Modified Davis classification: 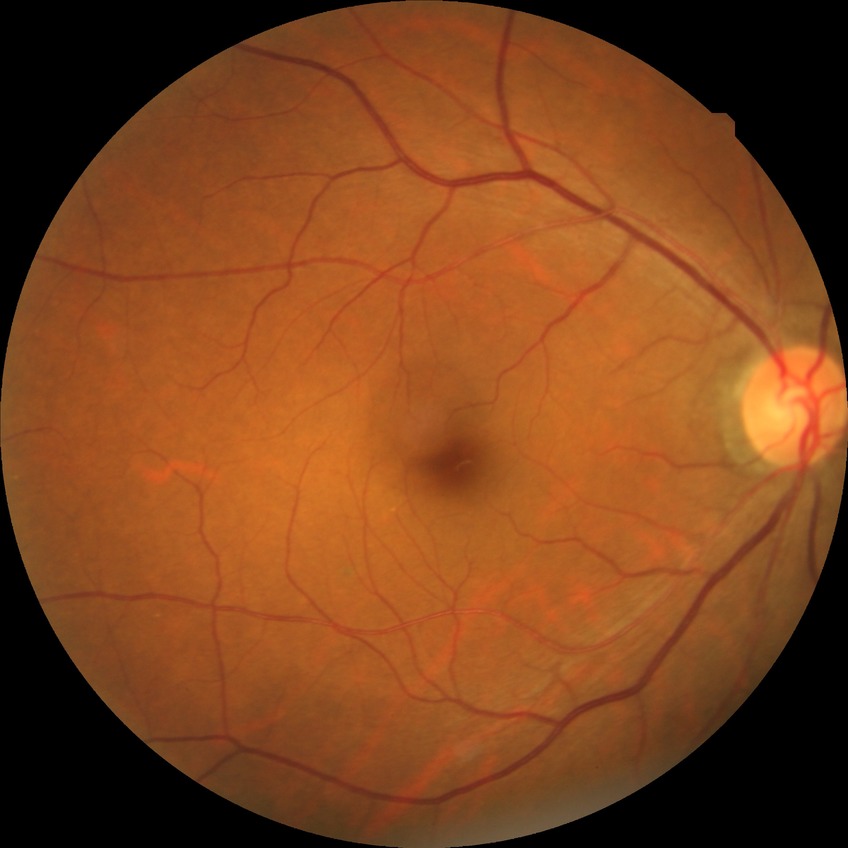
Davis DR grade is NDR.